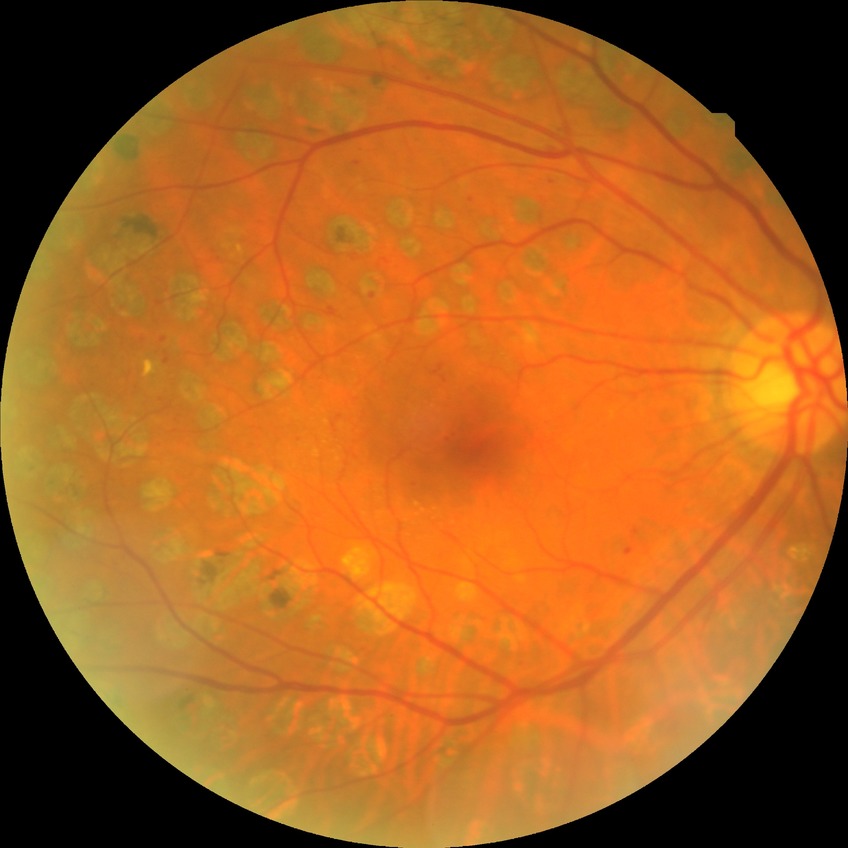

Diabetic retinopathy (DR) is PDR (proliferative diabetic retinopathy).